Without pupil dilation — 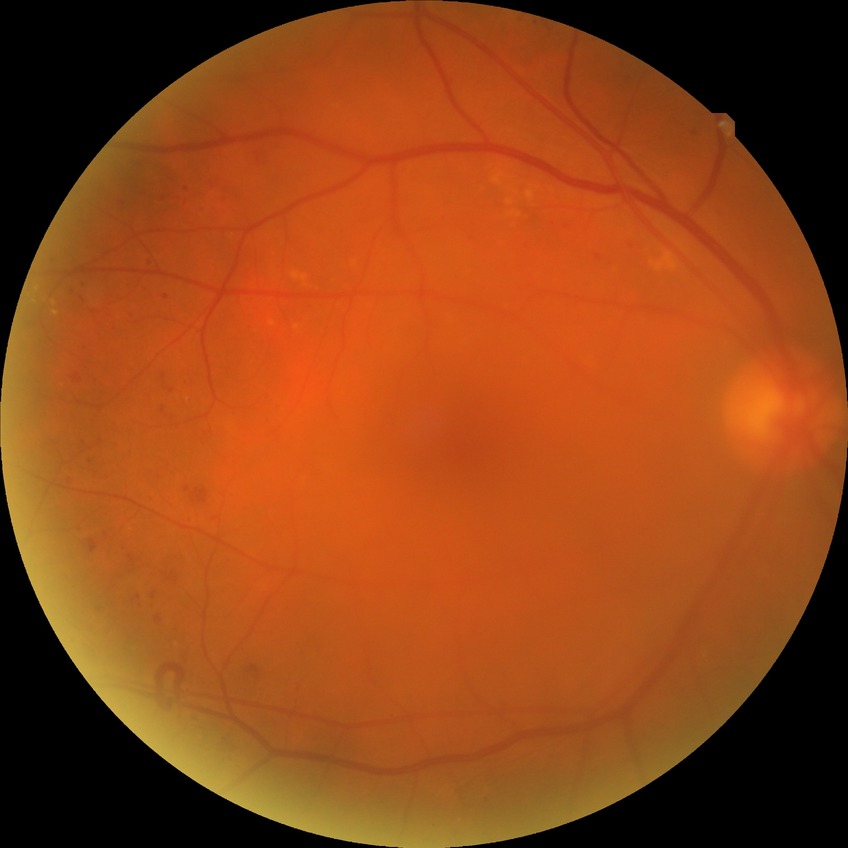
Modified Davis grading is pre-proliferative diabetic retinopathy. The retinopathy is classified as non-proliferative diabetic retinopathy.